45-degree field of view. Fundus photo:
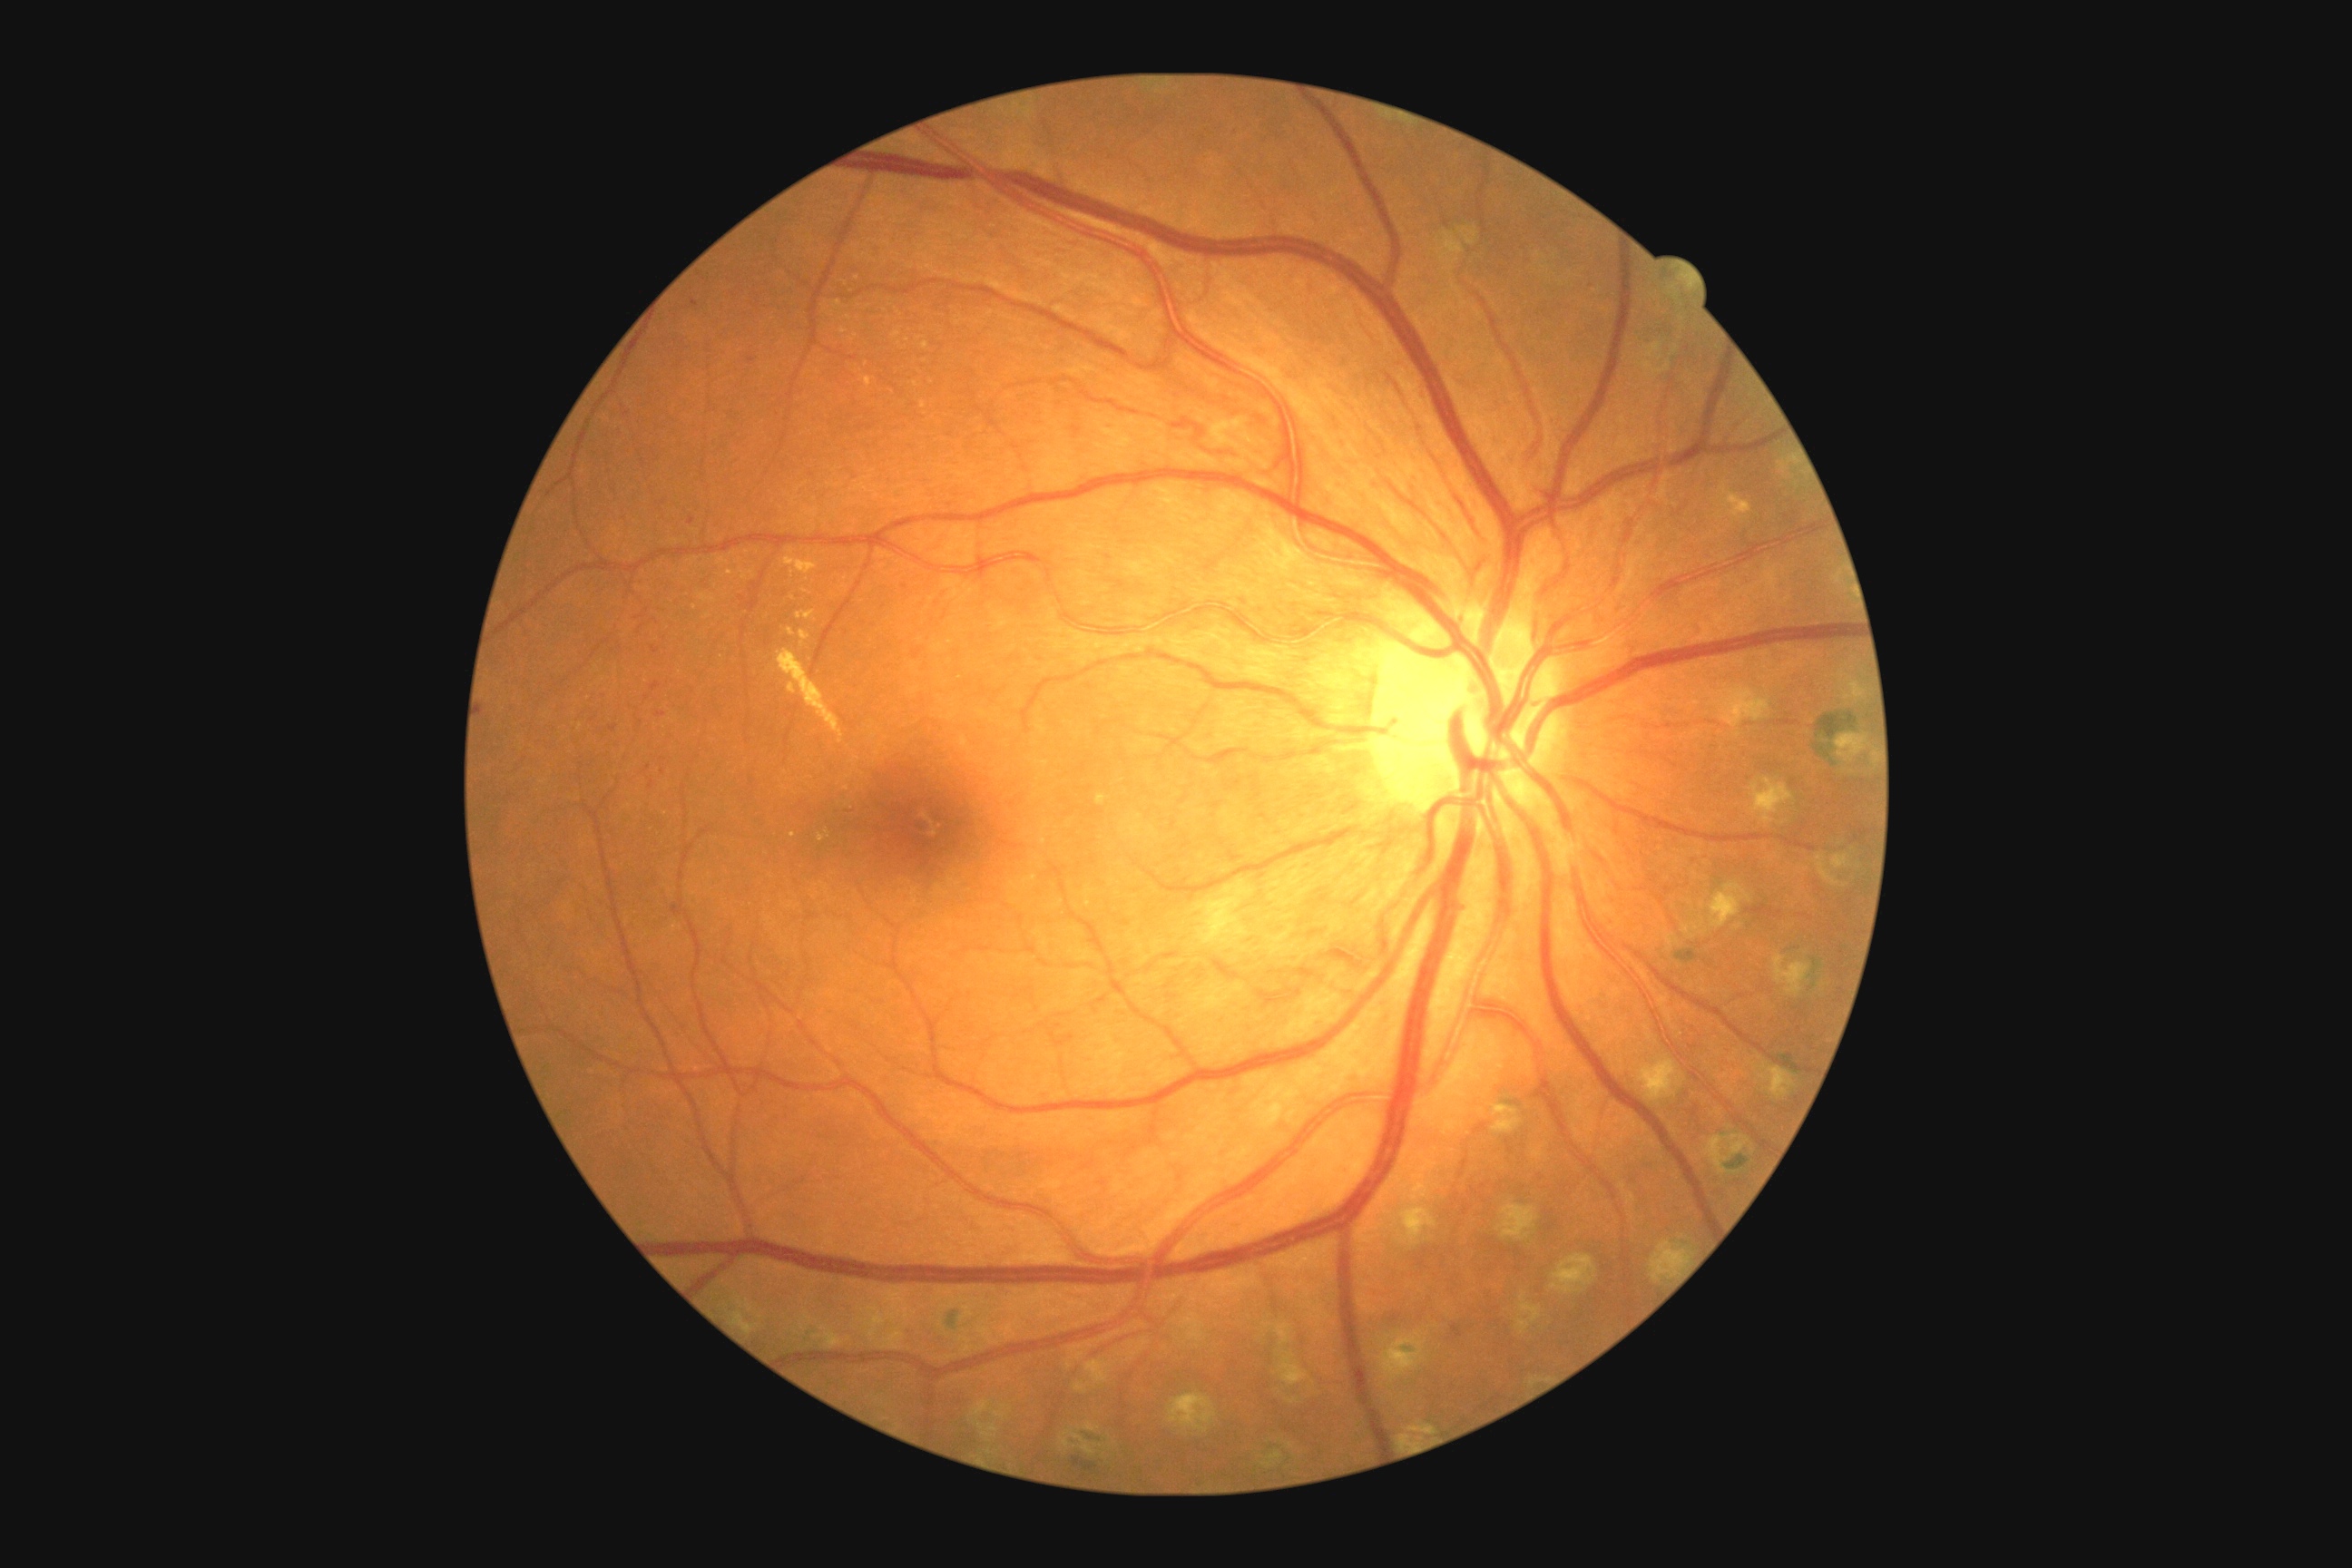 Diabetic retinopathy (DR) is grade 2 (moderate NPDR)
A subset of detected lesions:
hard exudates (EXs) (more not shown): 1720,484,1752,520; 892,331,901,340; 787,627,796,636; 798,611,816,622; 923,342,930,351; 1097,794,1108,807
Small EXs approximately at <pt>856,336</pt>; <pt>794,599</pt>; <pt>792,574</pt>; <pt>793,835</pt>; <pt>806,591</pt>; <pt>849,318</pt>; <pt>920,338</pt>